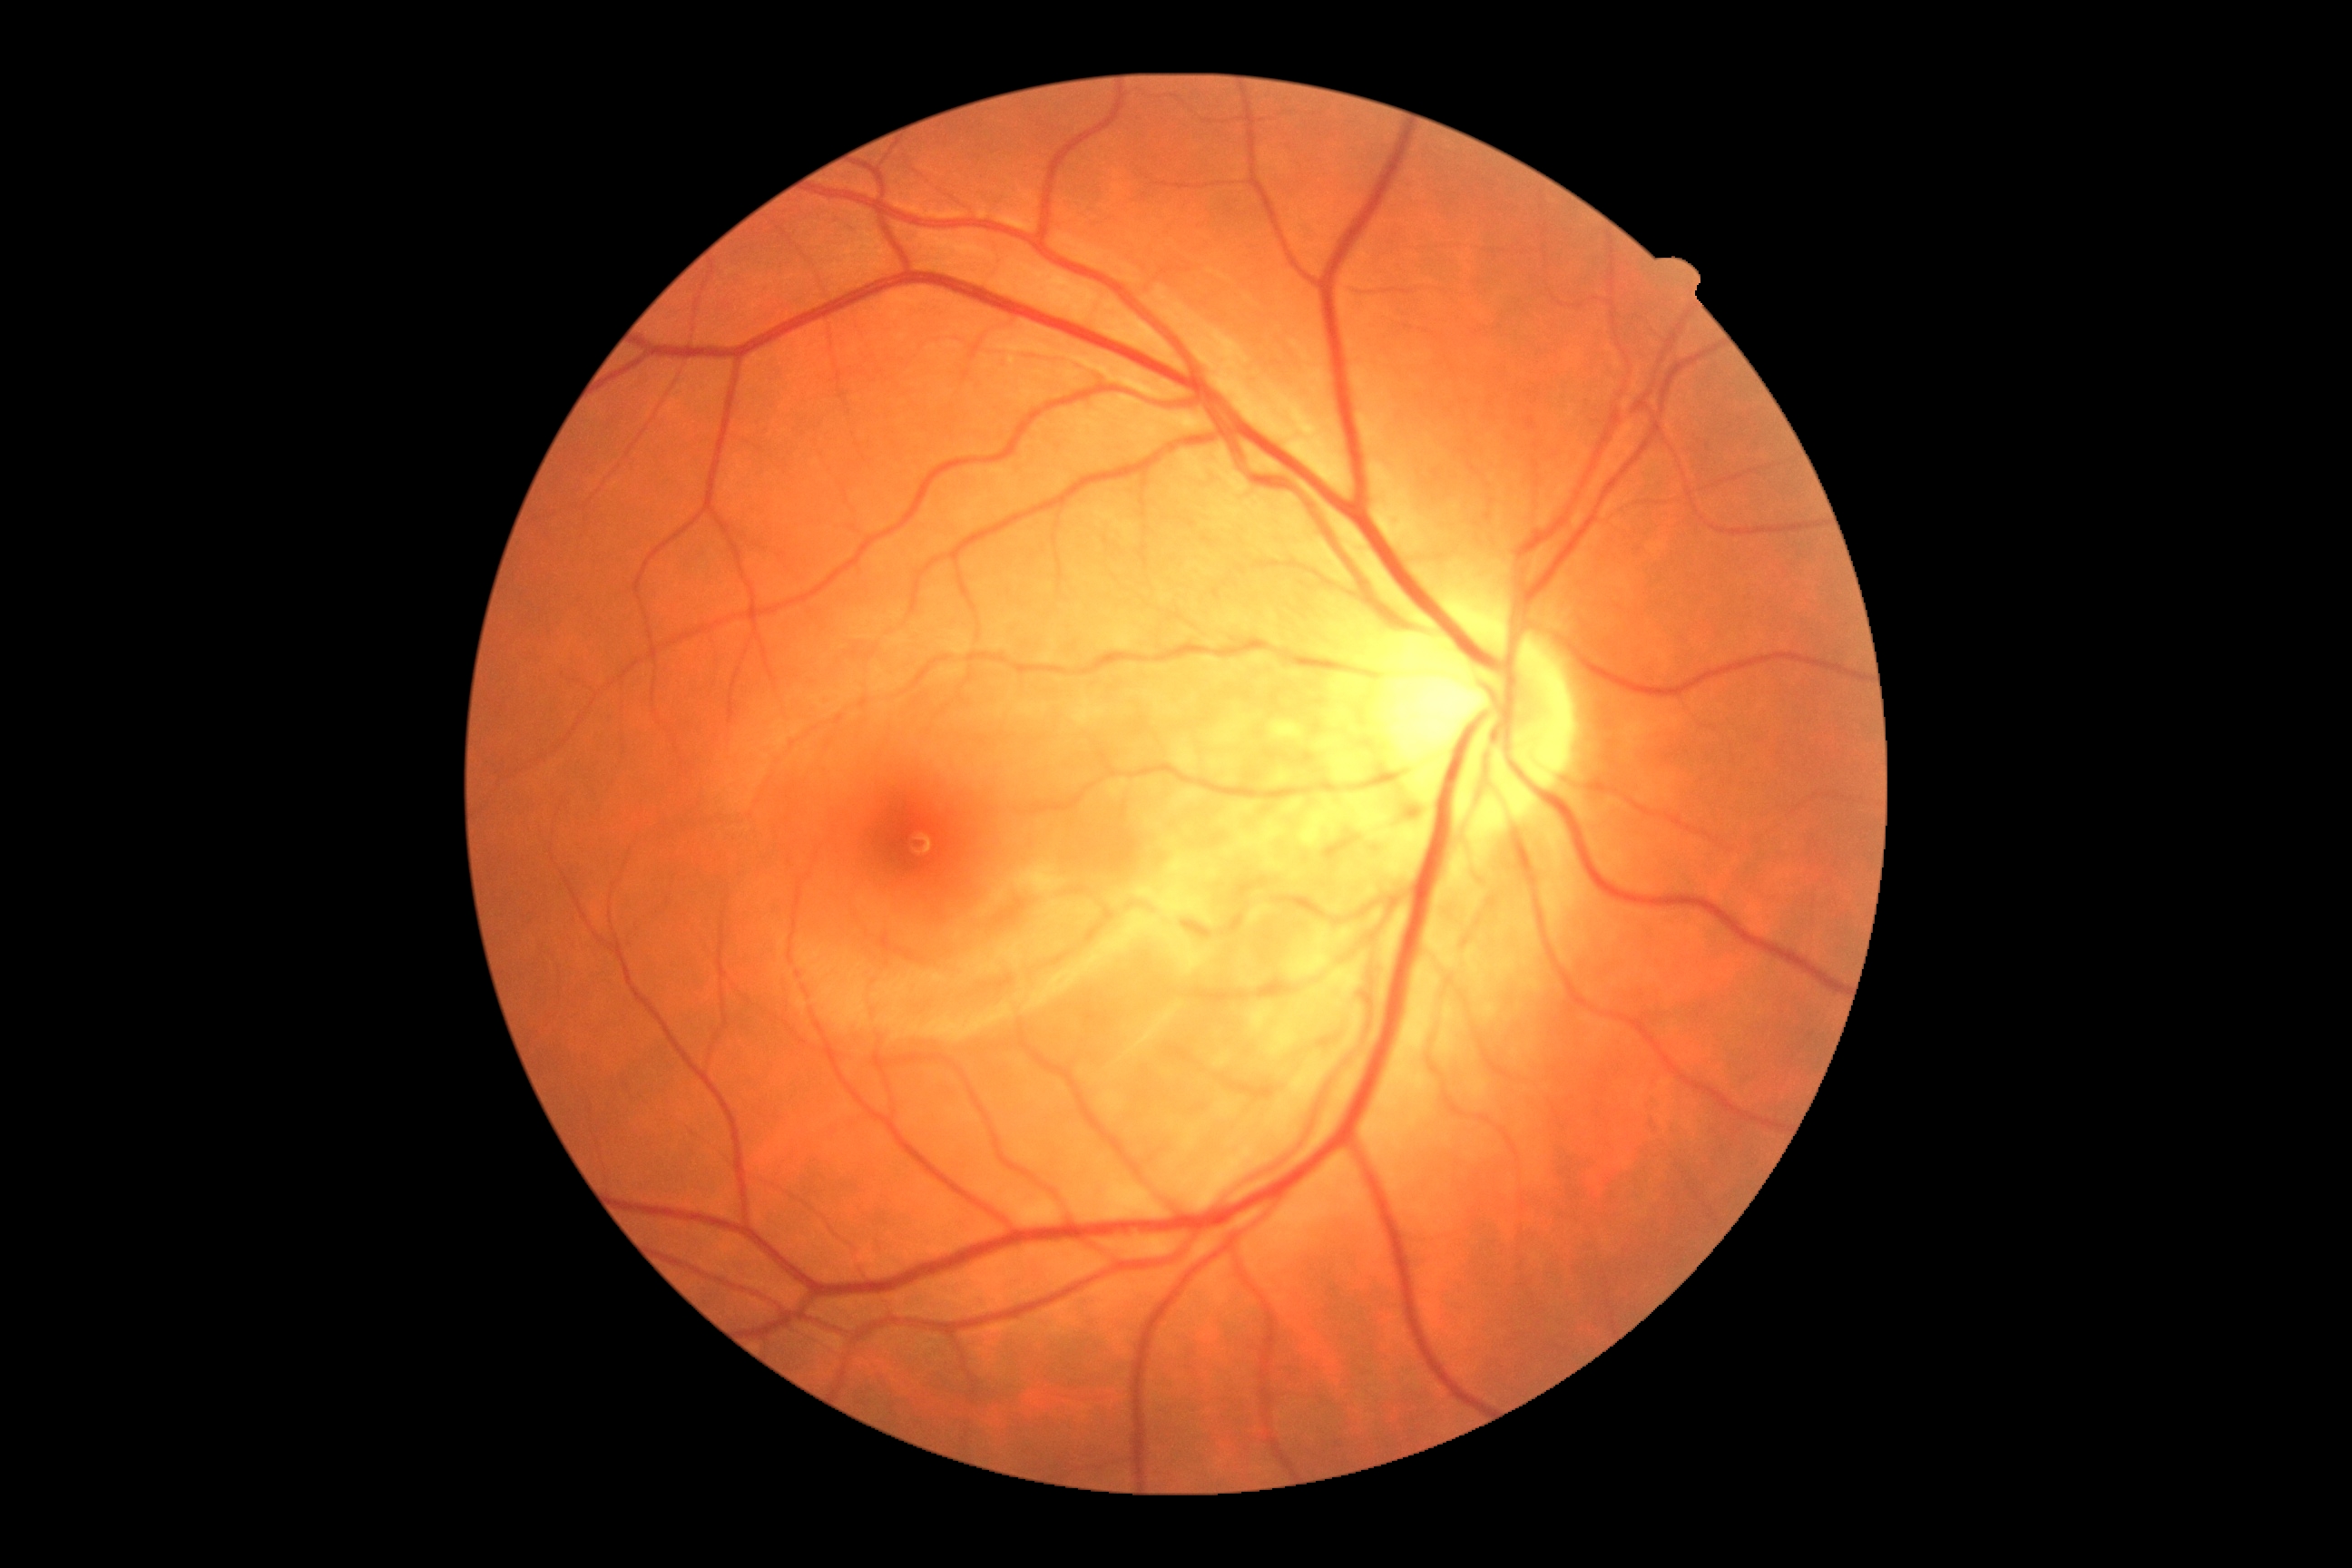 Diabetic retinopathy (DR) is no apparent diabetic retinopathy (grade 0) — no visible signs of diabetic retinopathy.